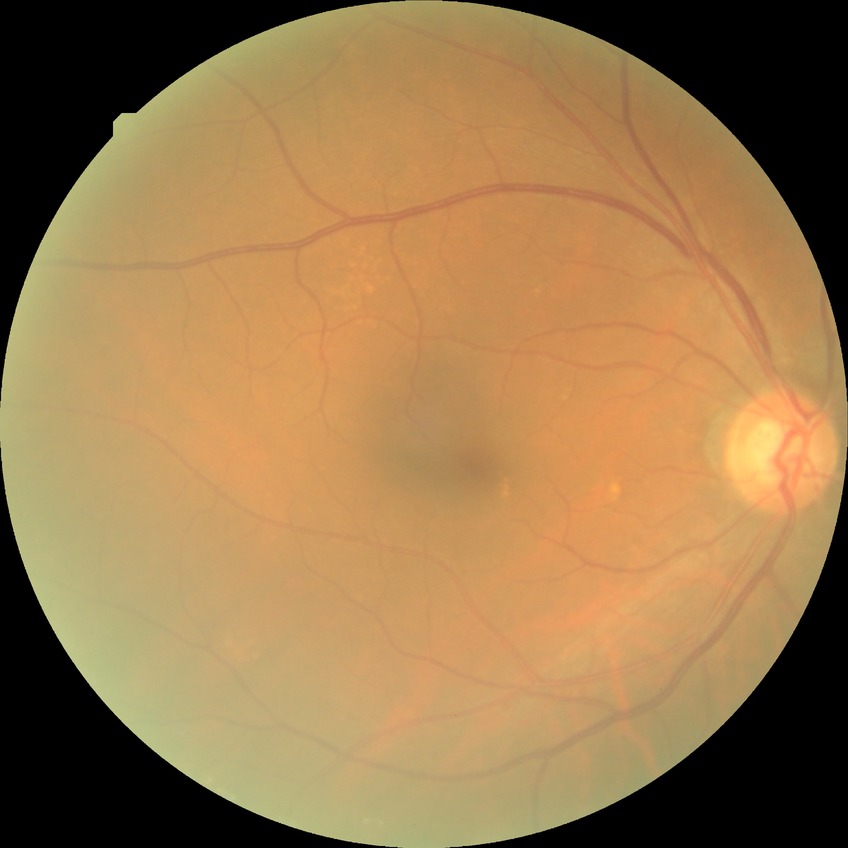
Modified Davis classification: no diabetic retinopathy.